Without pupil dilation; acquired with a NIDEK AFC-230.
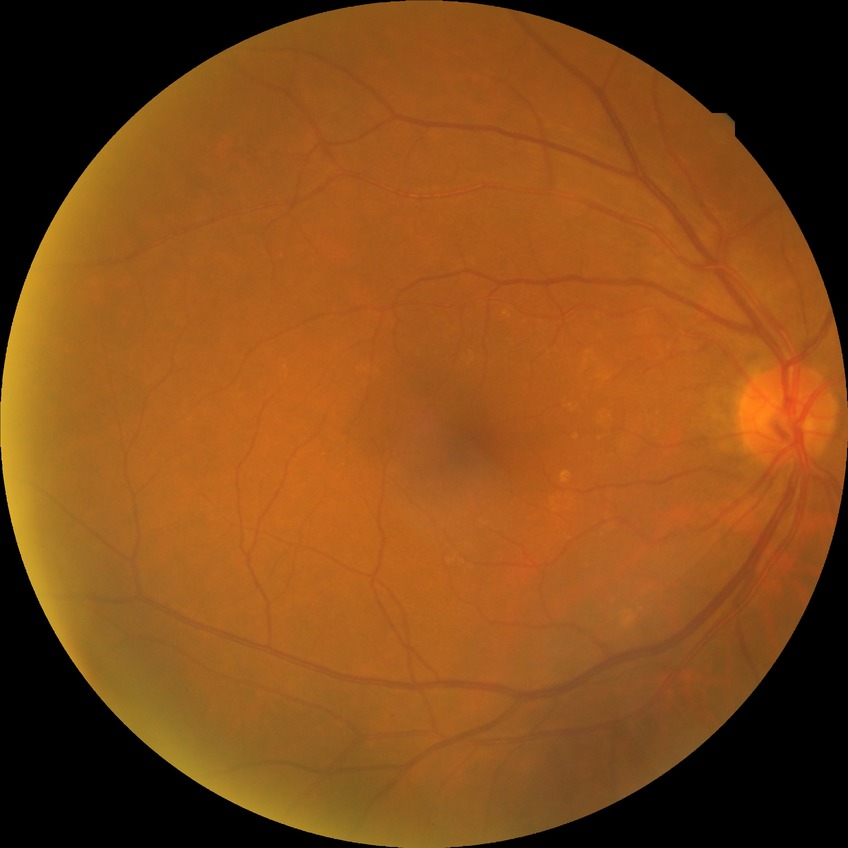

- DR grade — NDR